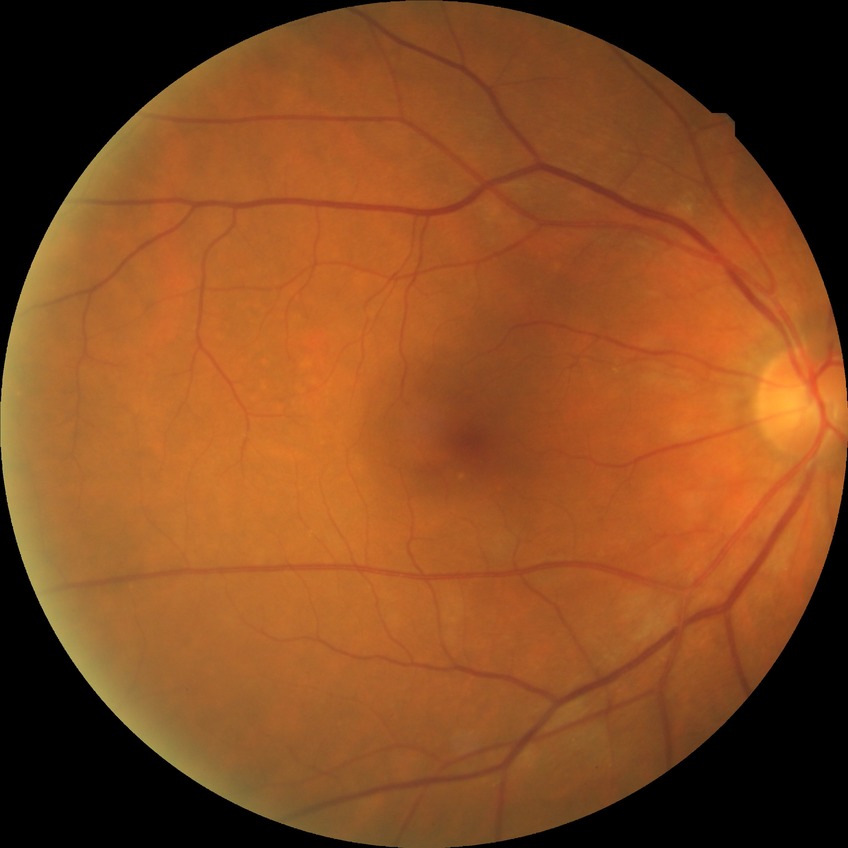
diabetic retinopathy severity@no diabetic retinopathy.